Fundus photo — 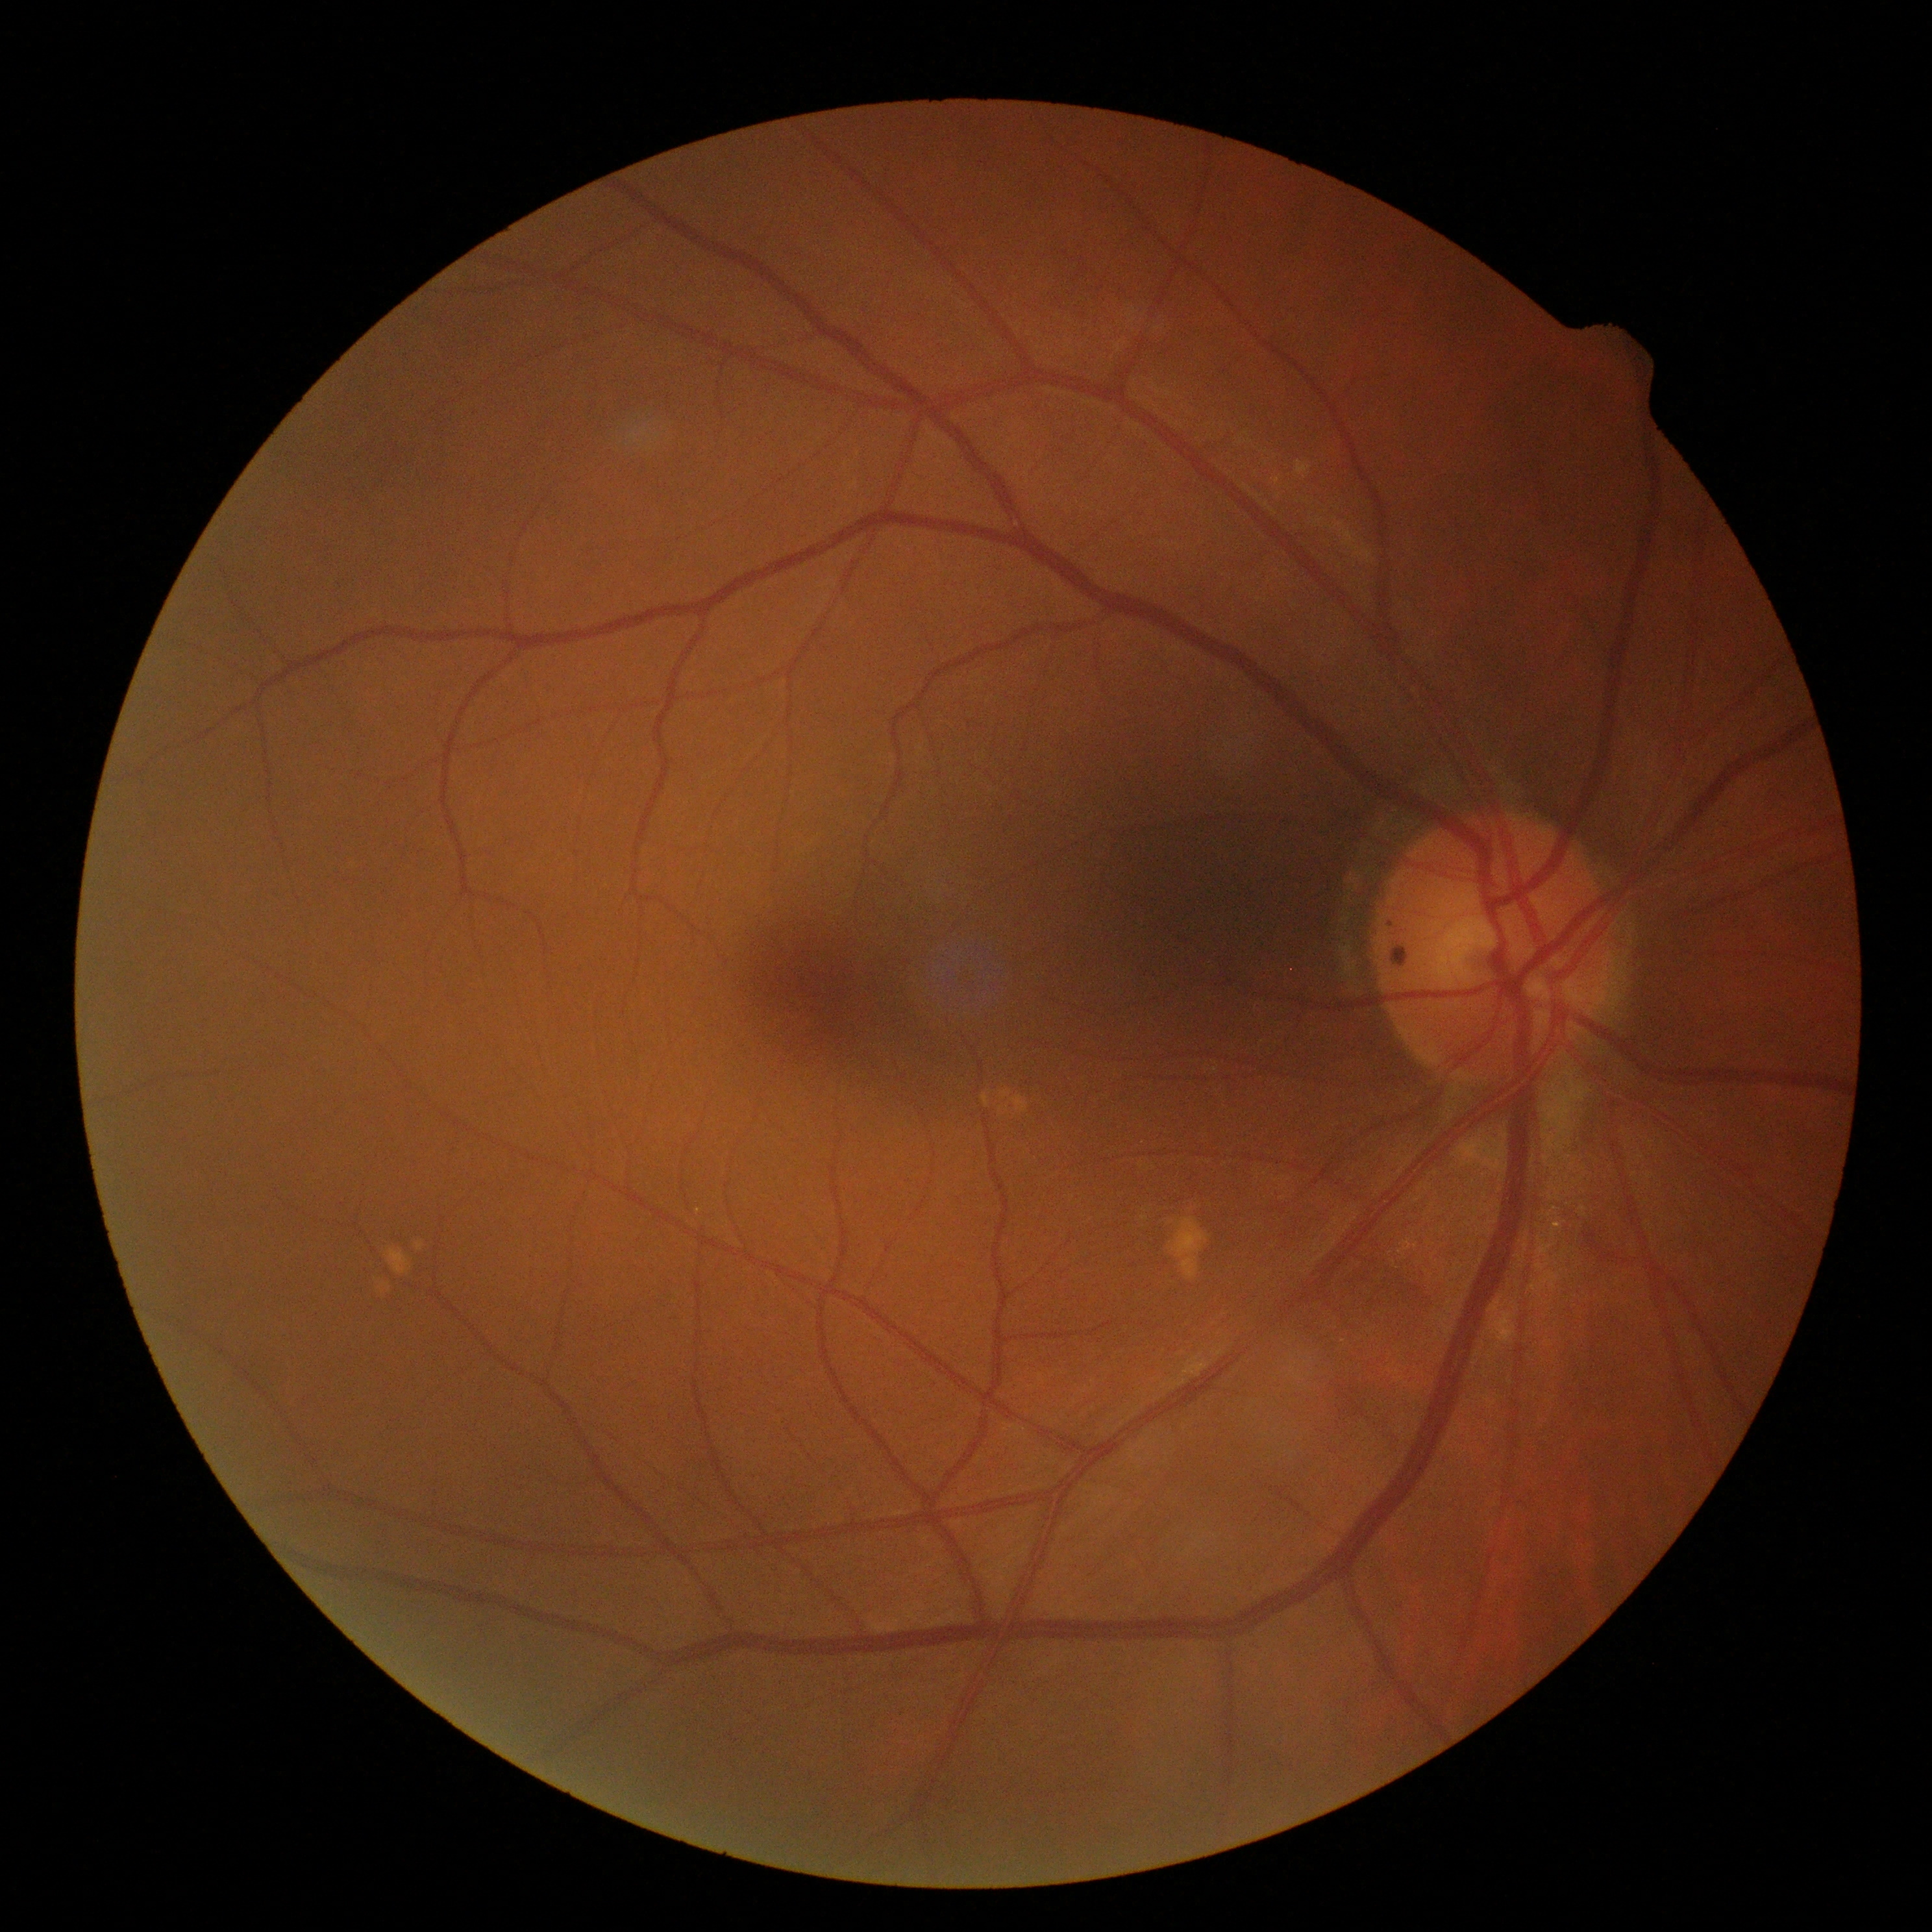
diabetic retinopathy severity = grade 0.